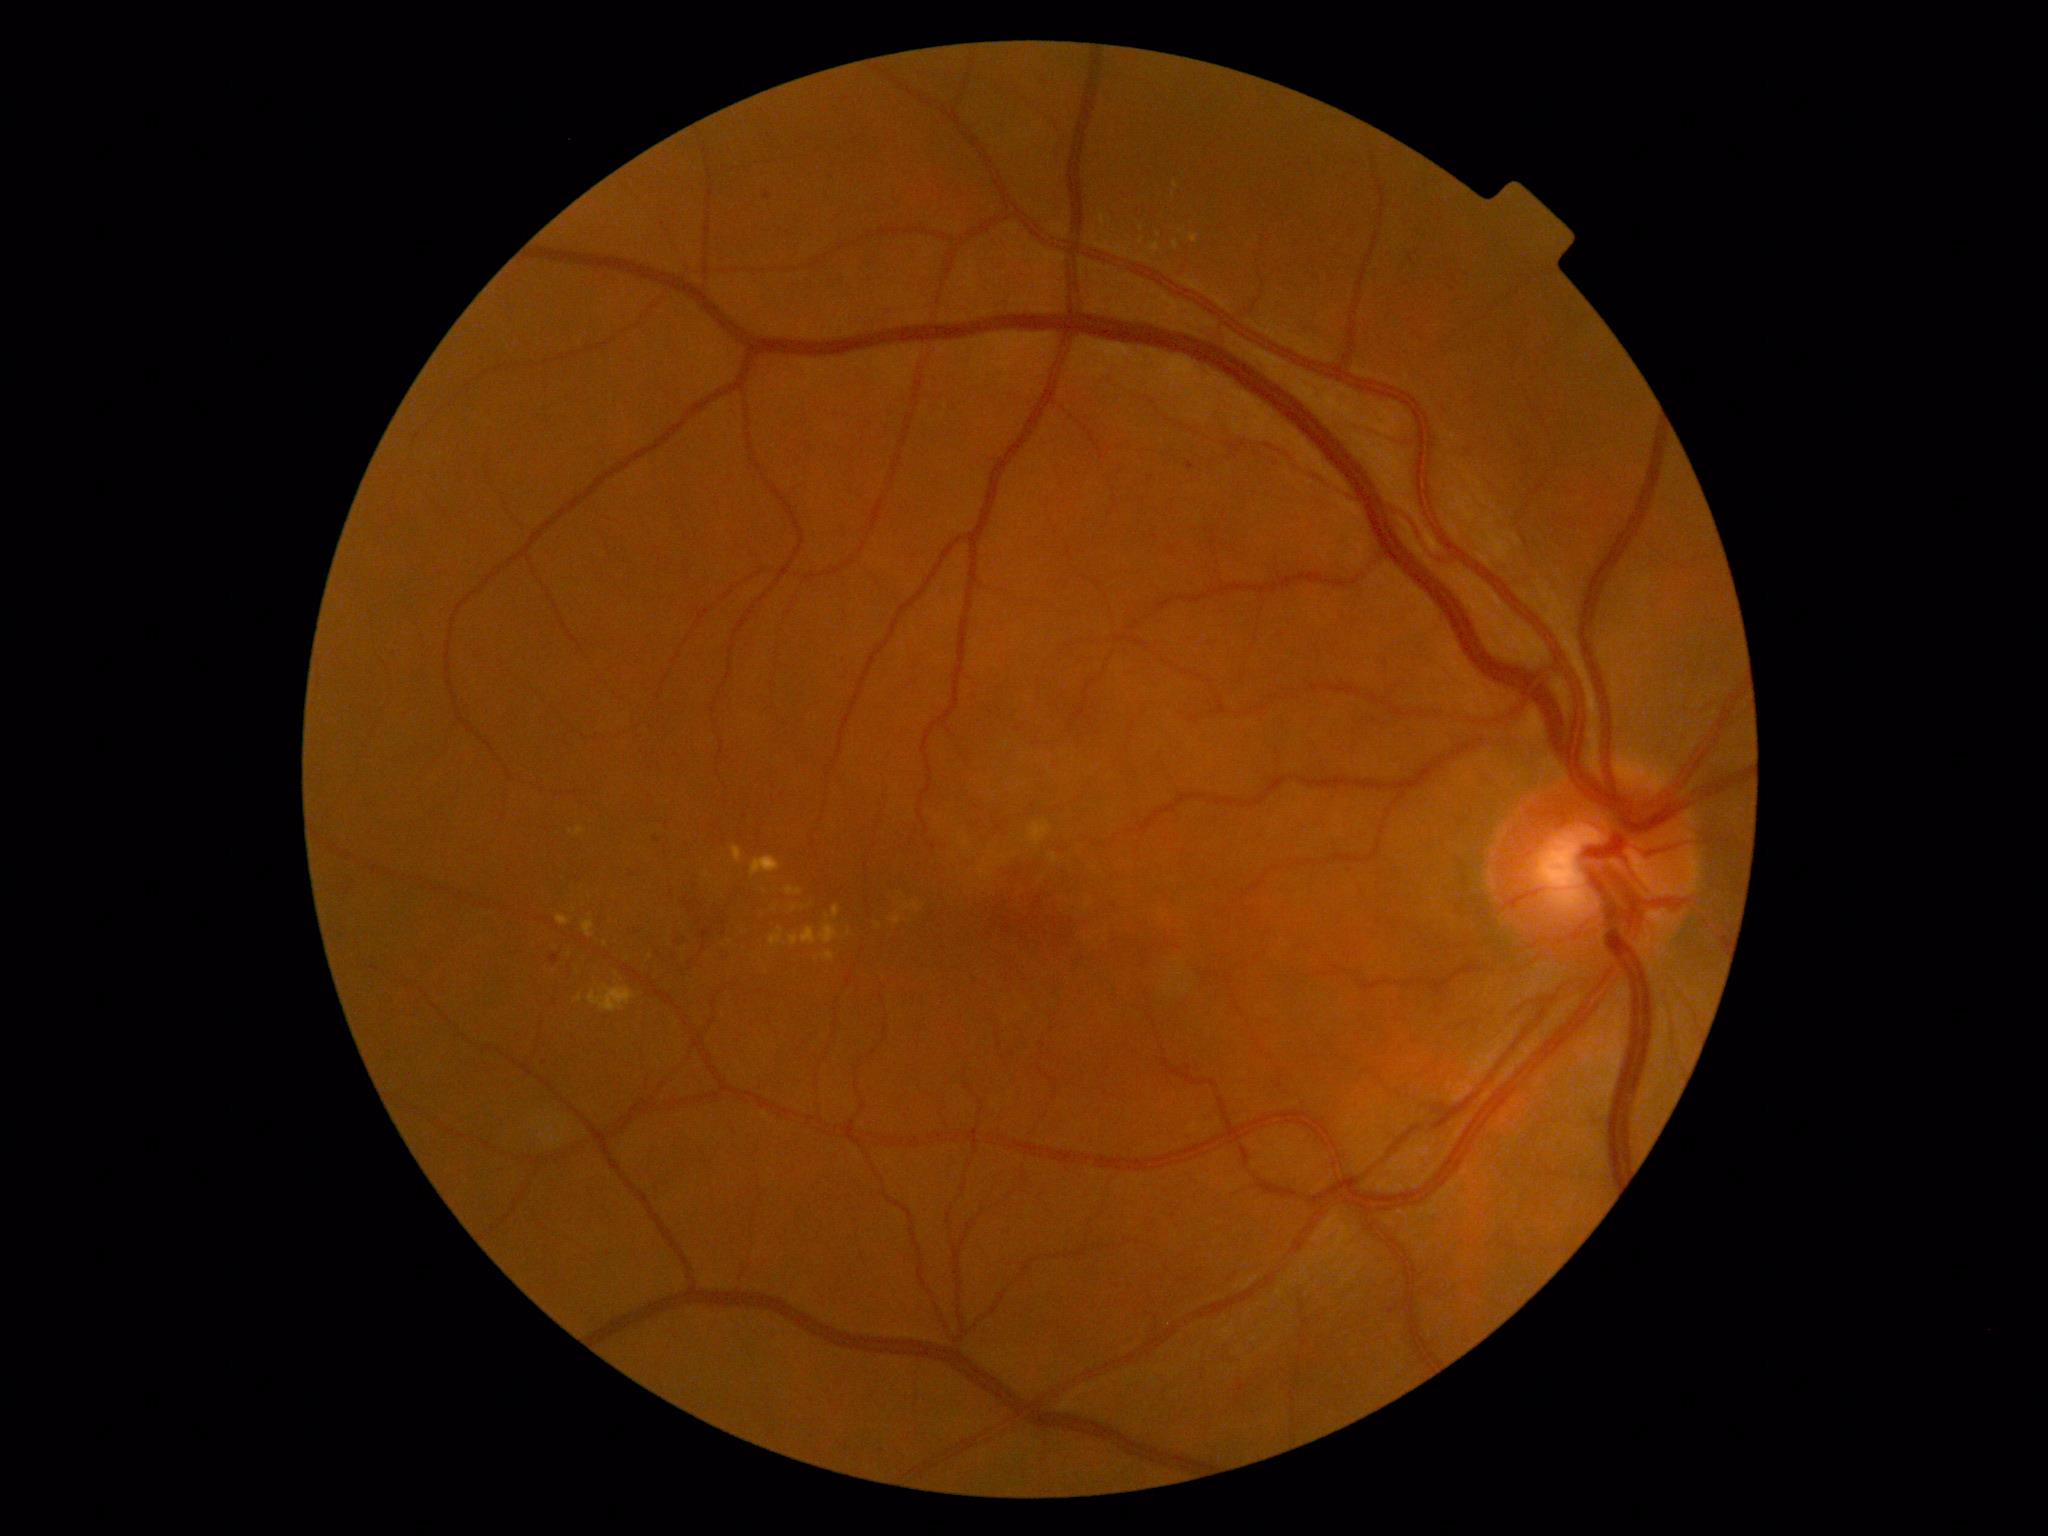 Diabetic retinopathy (DR) is grade 2 (moderate NPDR).